Nonmydriatic. Camera: NIDEK AFC-230. Diabetic retinopathy graded by the modified Davis classification: 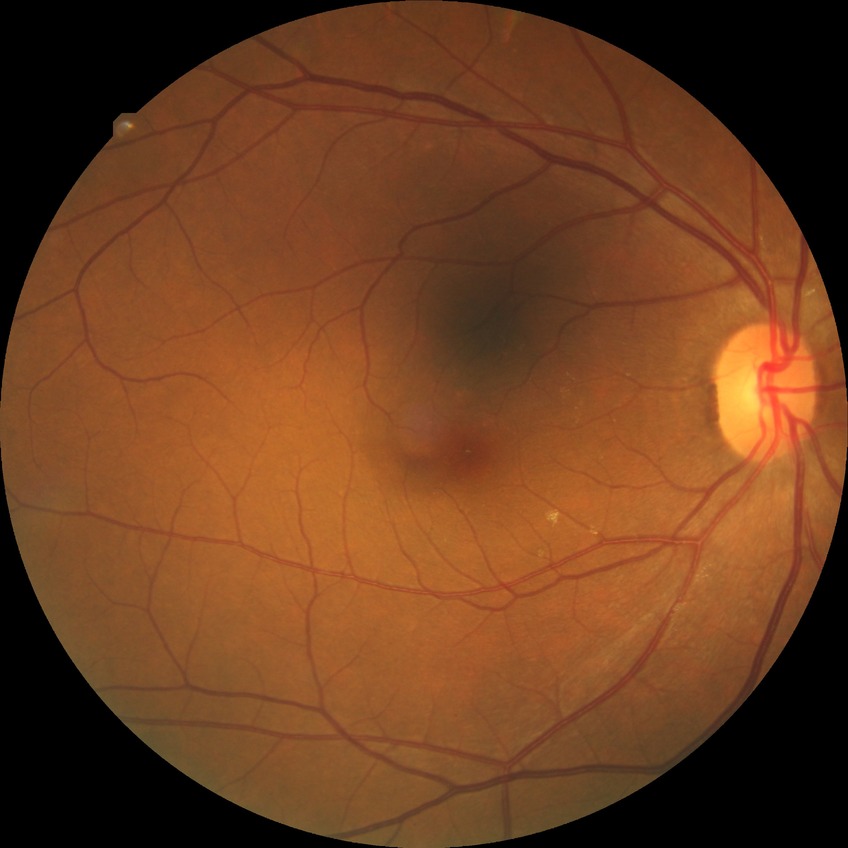

Annotations:
- diabetic retinopathy (DR): no diabetic retinopathy (NDR)